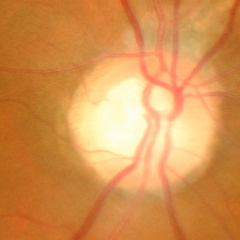

Optic disc appearance consistent with advanced glaucoma.